Disc-centered fundus crop — 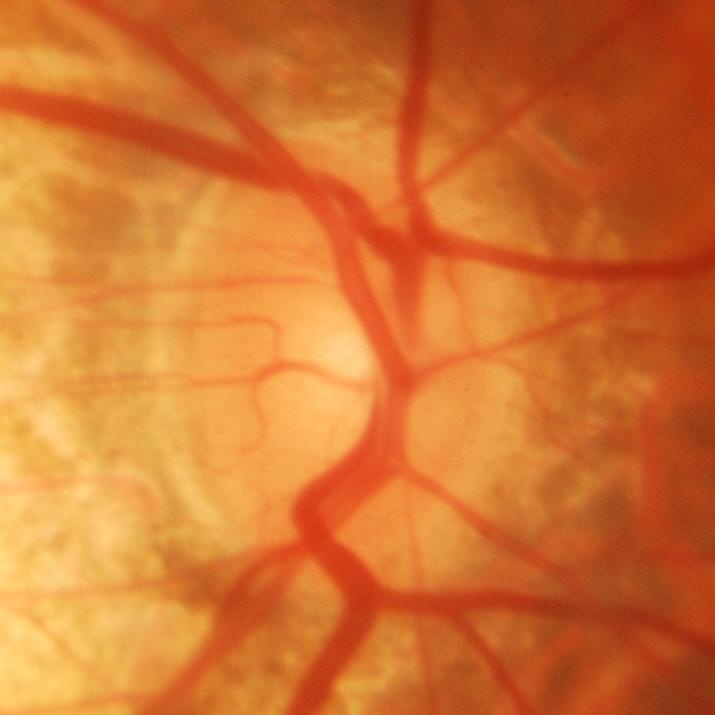

Evidence of glaucoma.